Color fundus photograph · 45° field of view · 1932x1932px — 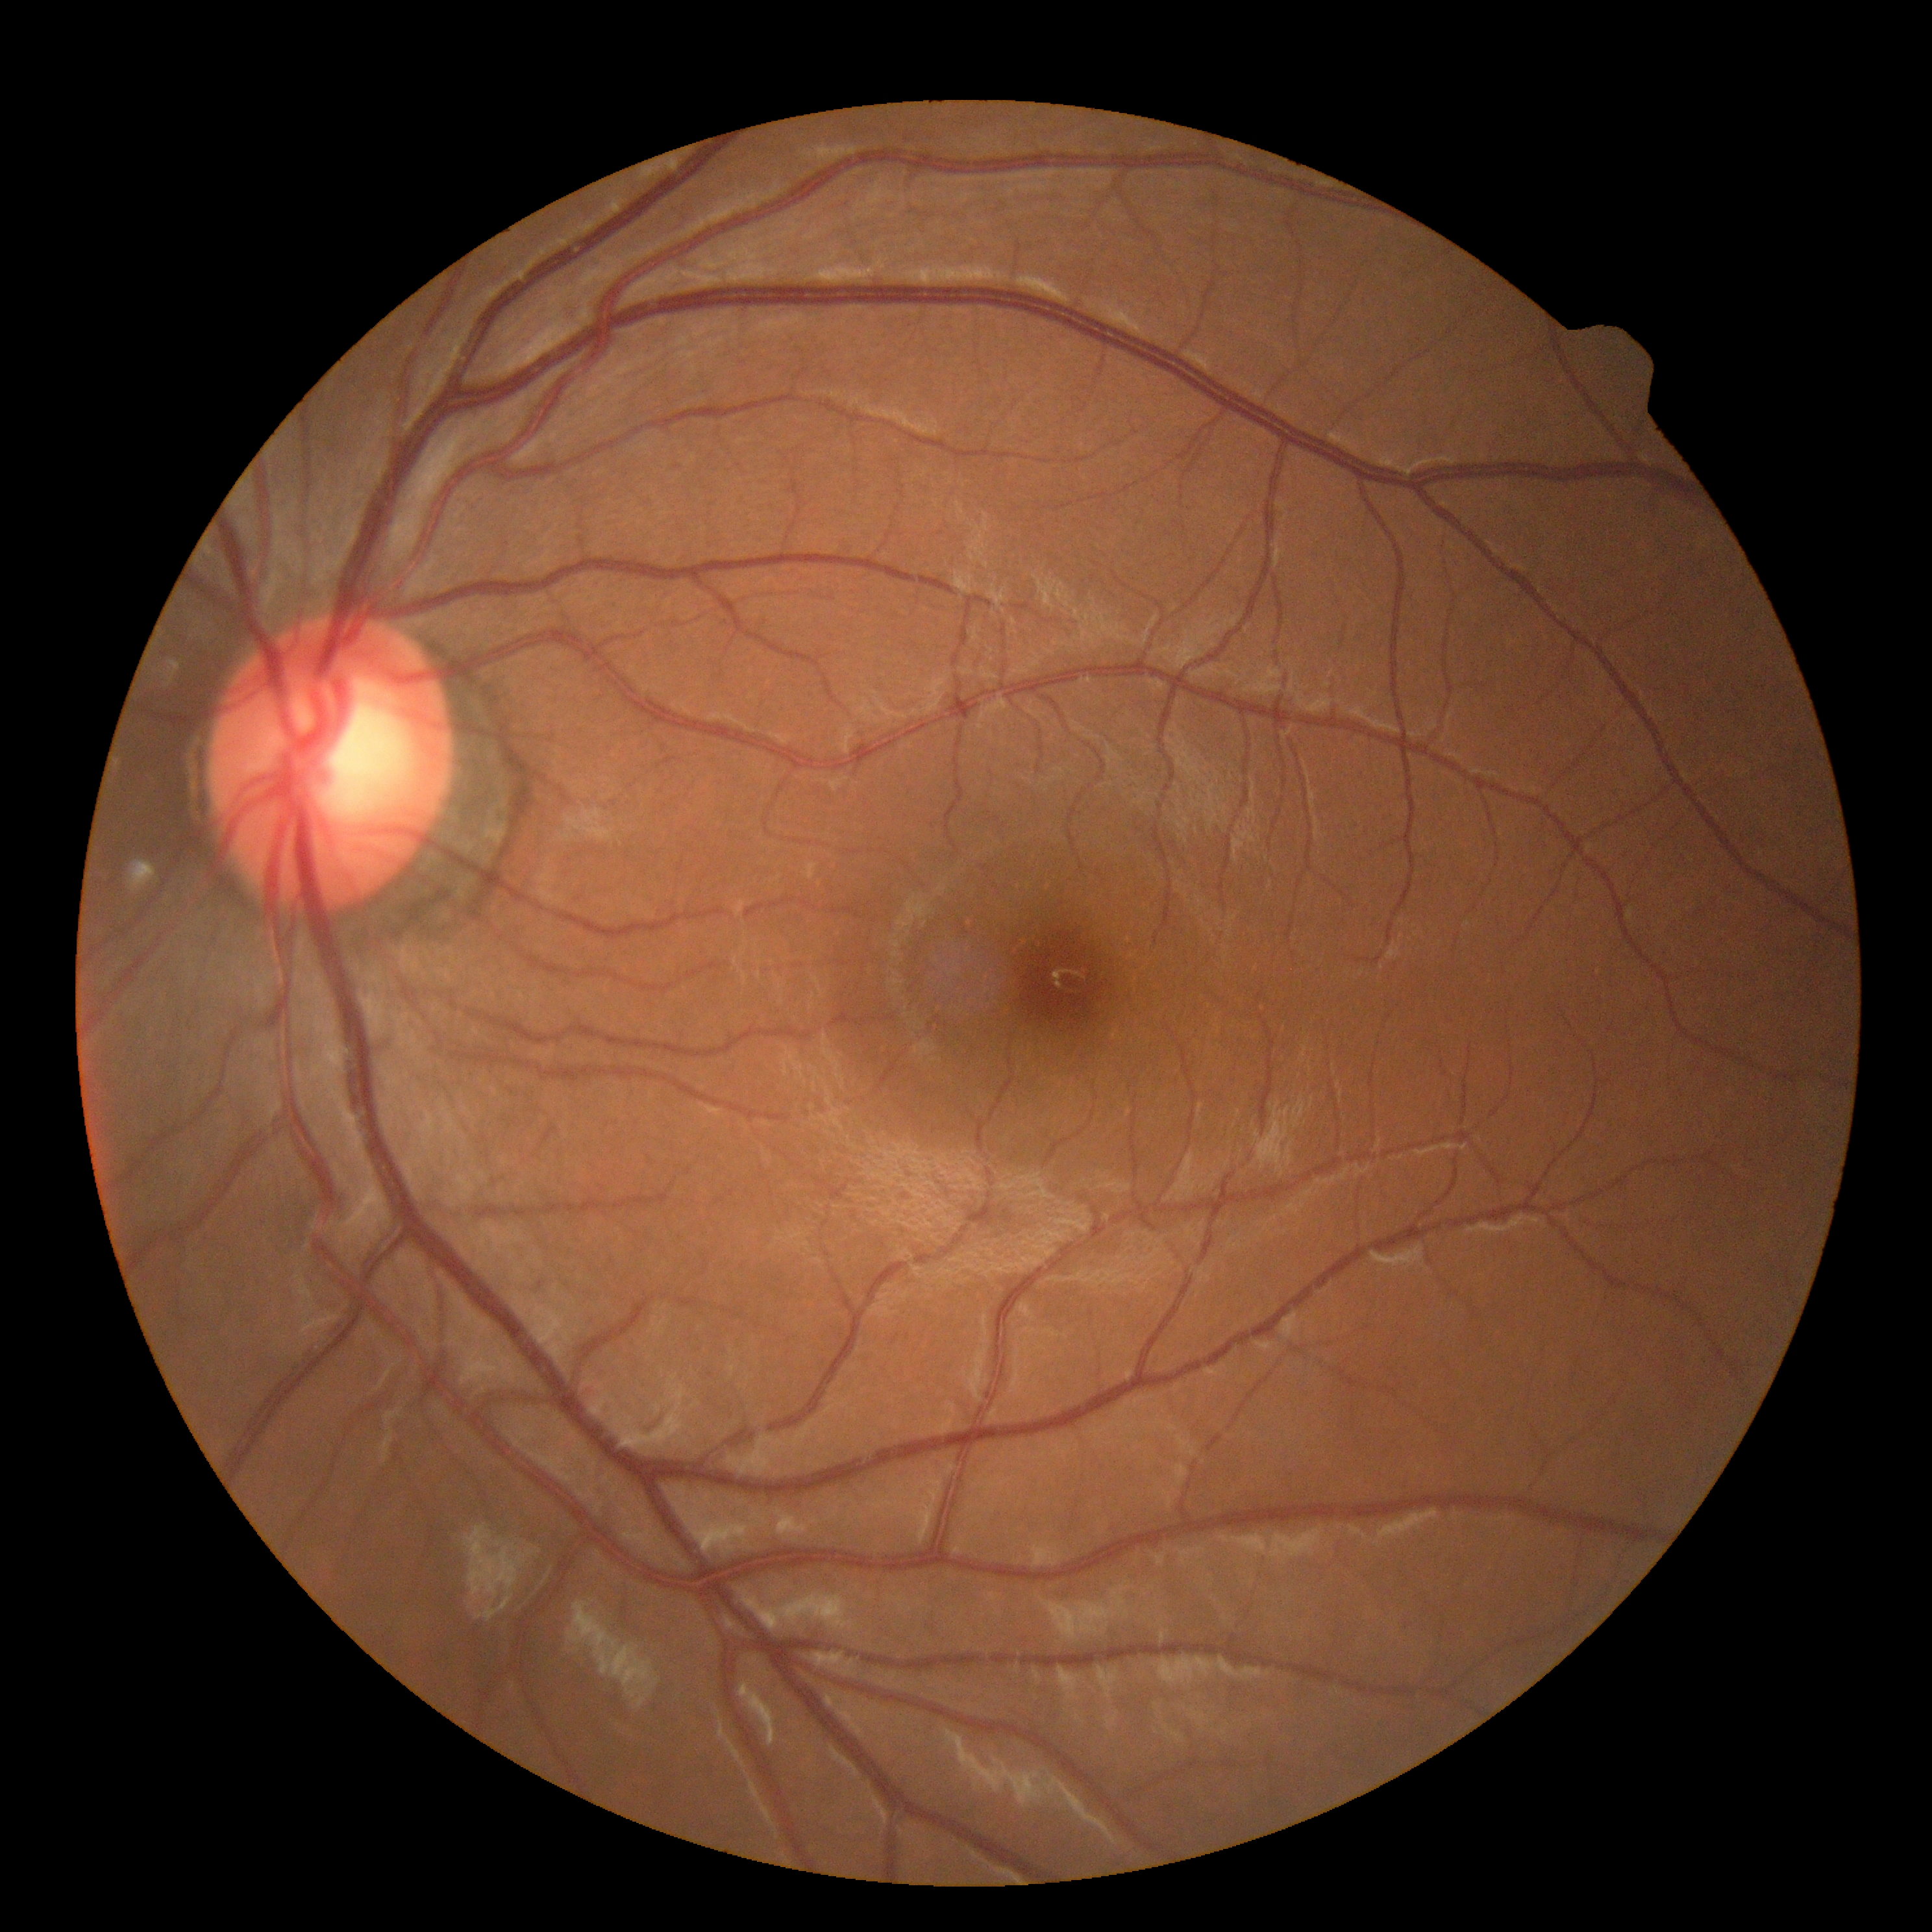

DR grade: 0 (no apparent retinopathy).
No DR findings.